1240 by 1240 pixels; wide-field fundus image from infant ROP screening — 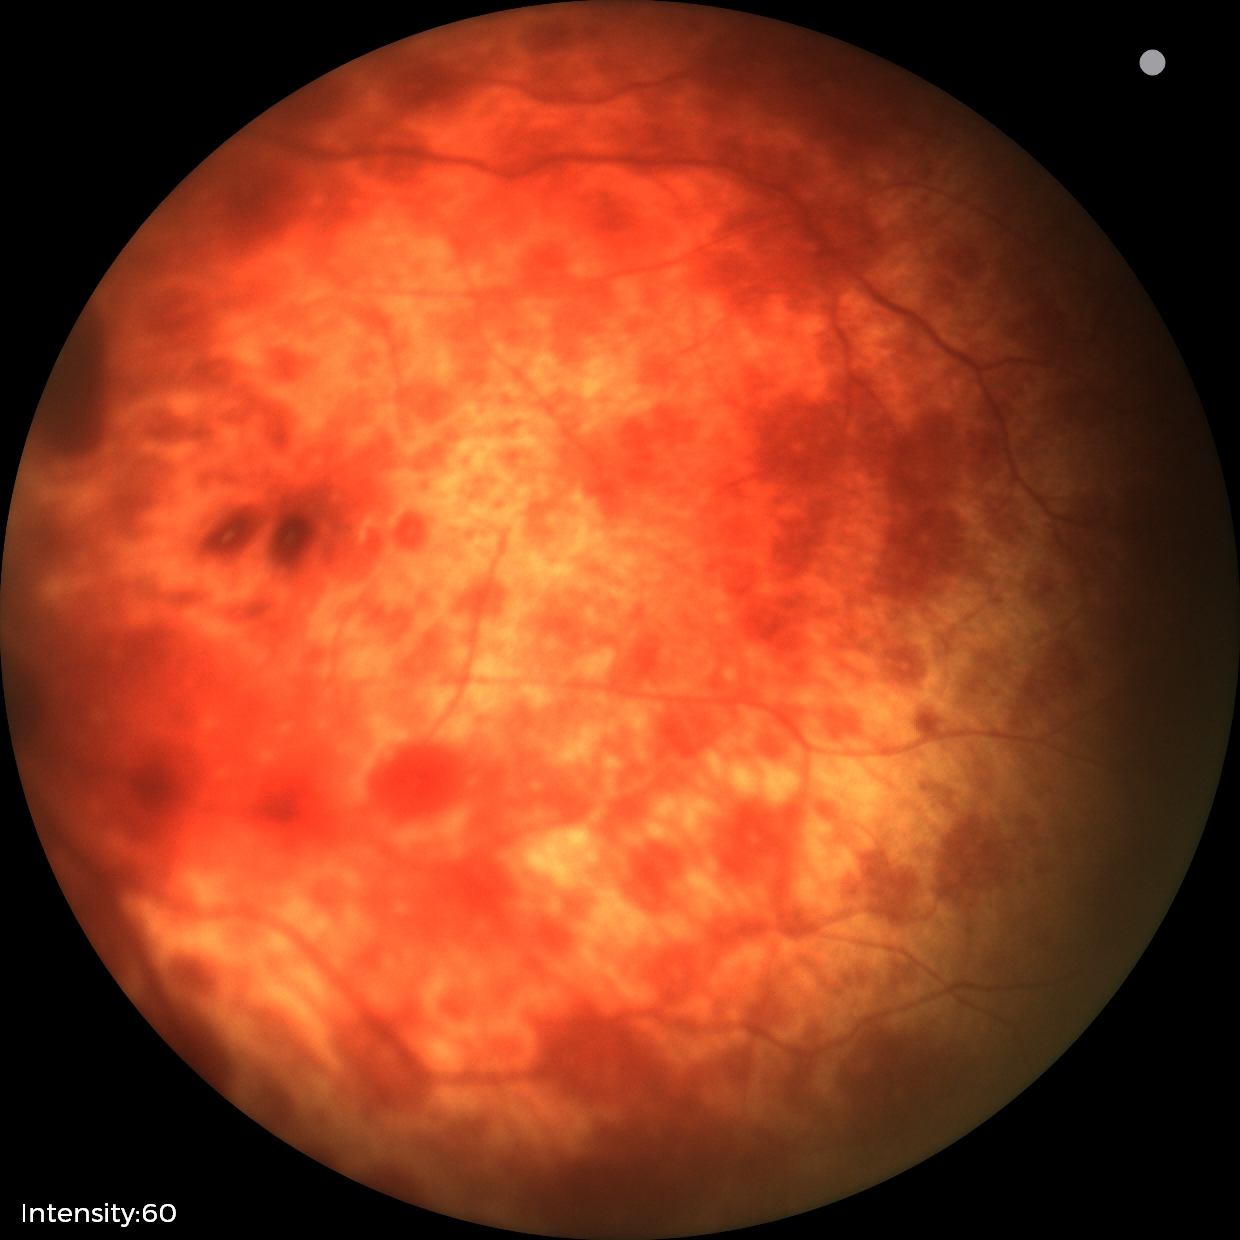

Screening diagnosis: retinal hemorrhages.